Camera: Kowa VX-10α, 50° field of view, fundus photo, image size 2361x1568, macula-centered, mydriatic (tropicamide 0.5%): 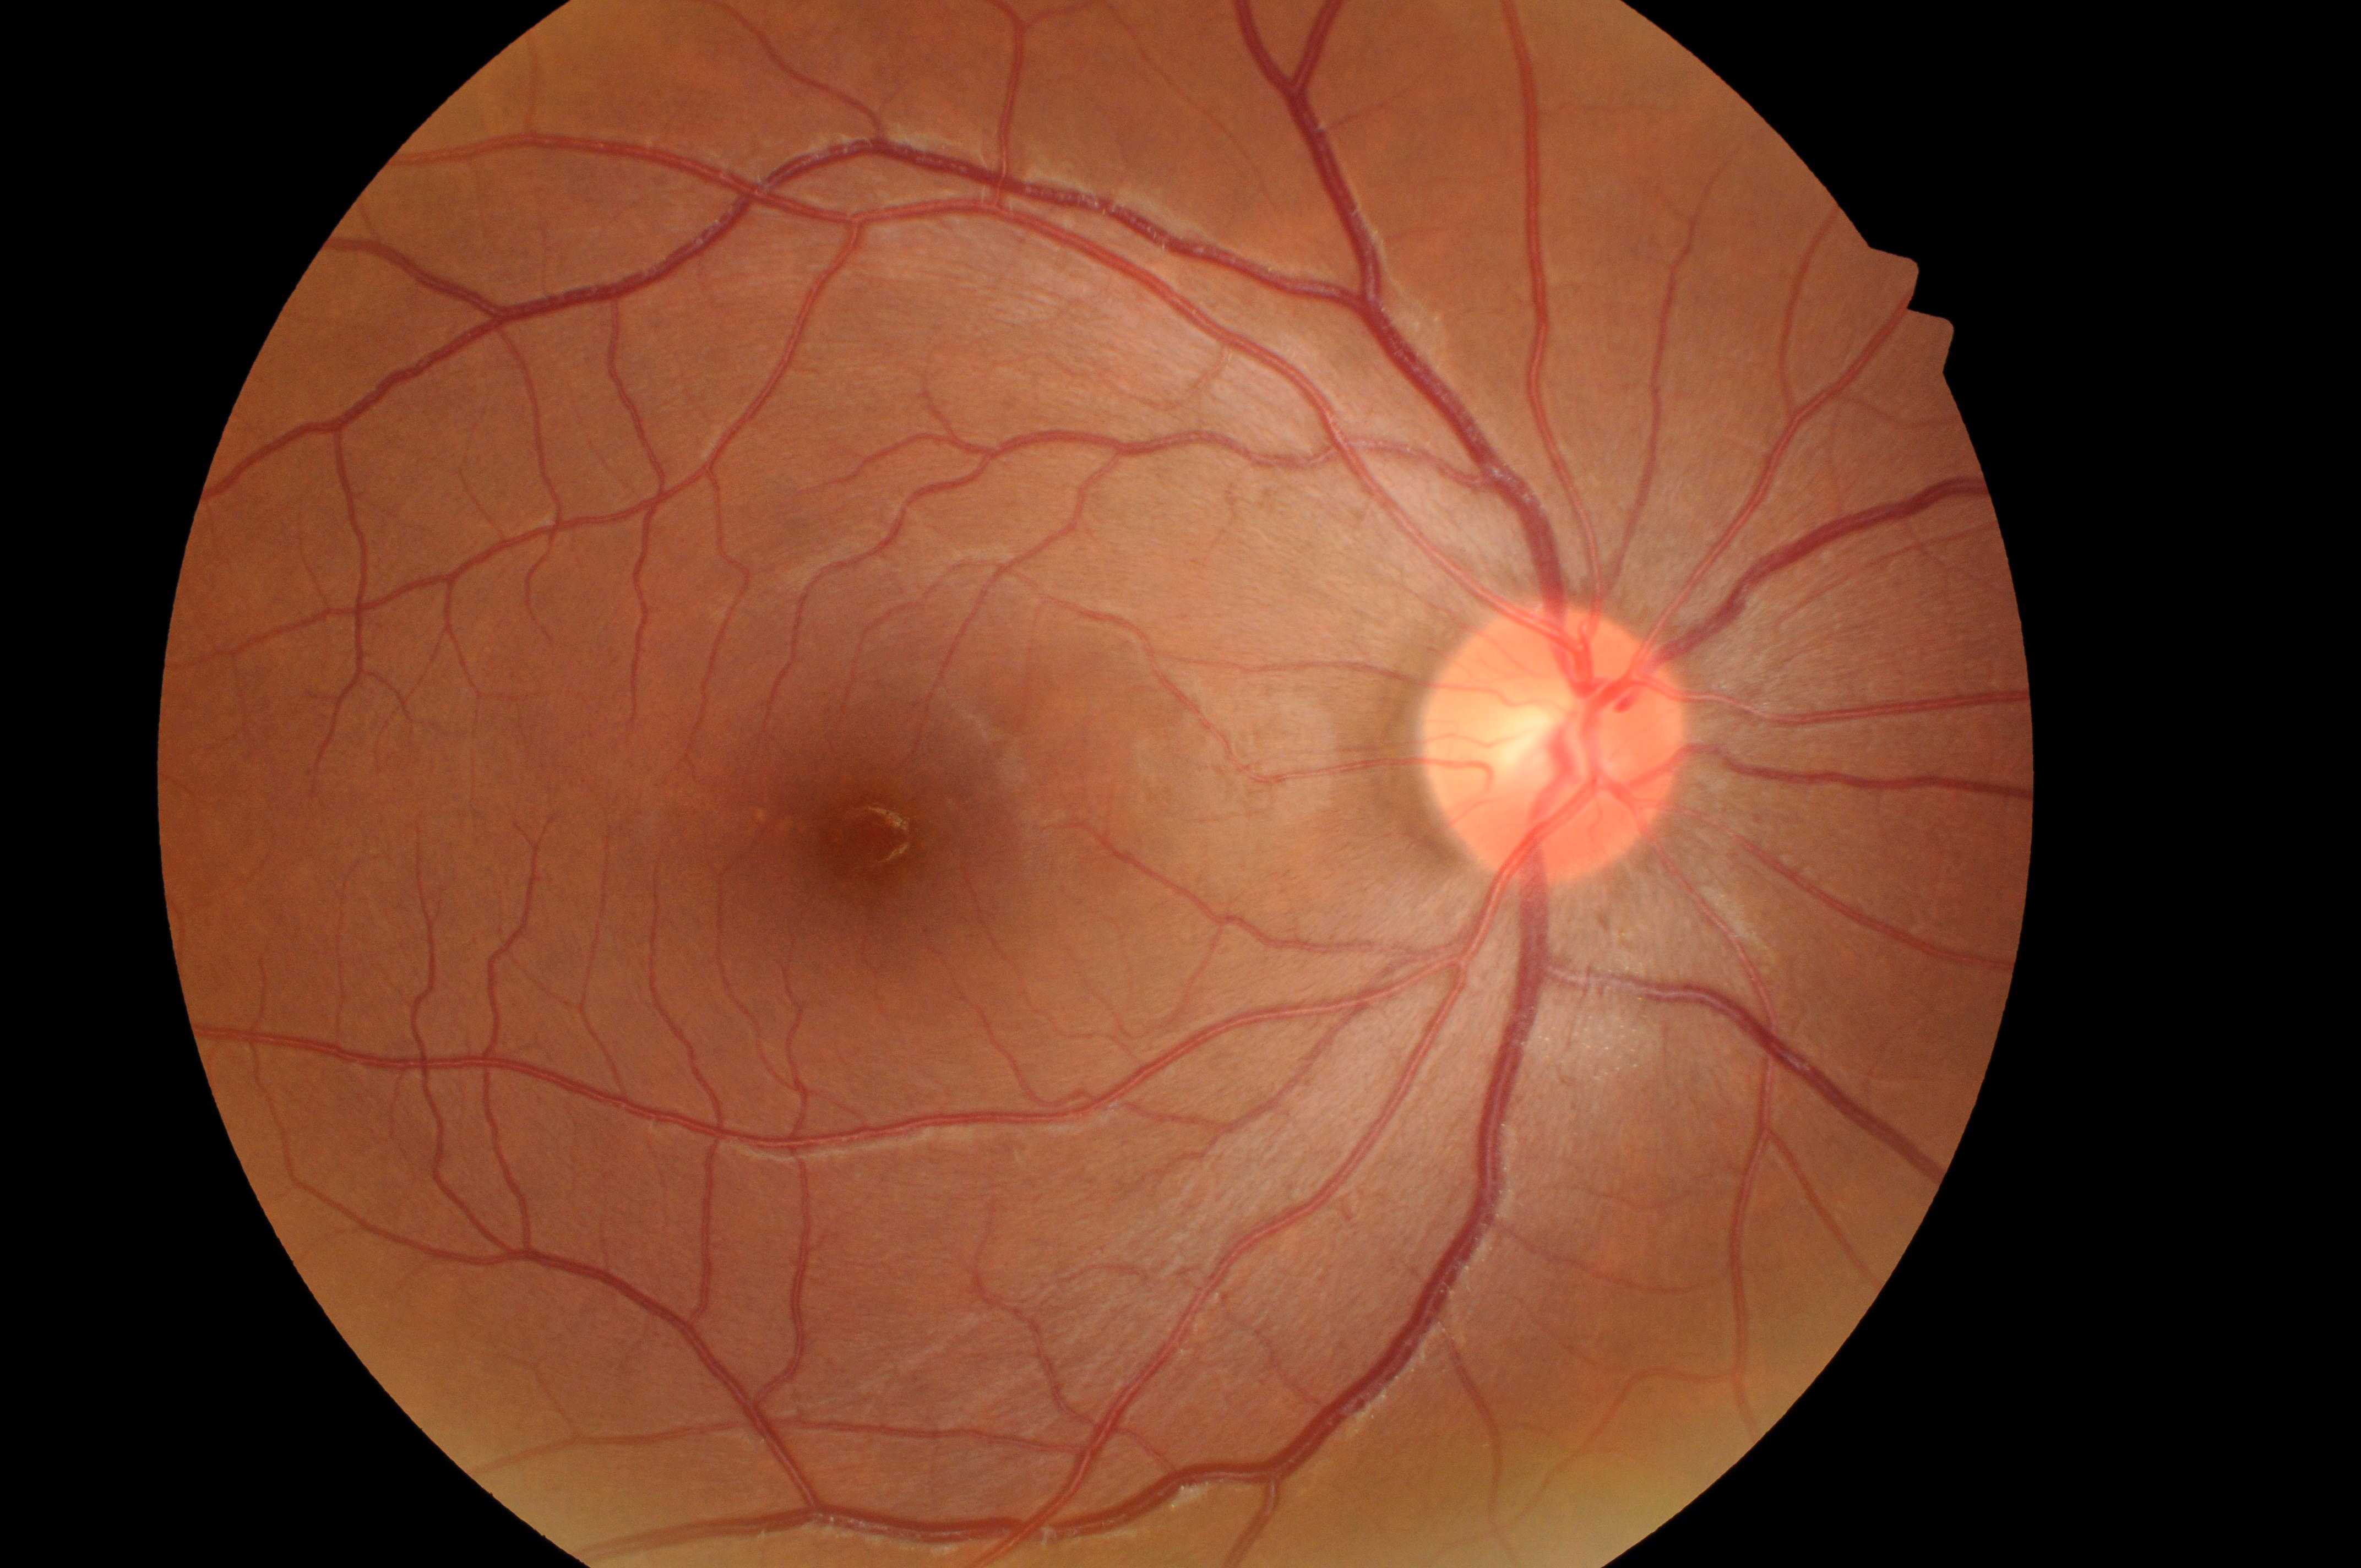

Diabetic retinopathy (DR): 0/4.
Foveal center: 879px, 843px.
The optic disc is at 1547px, 746px.
Diabetic macular edema (DME): 0.
Imaged eye: right.